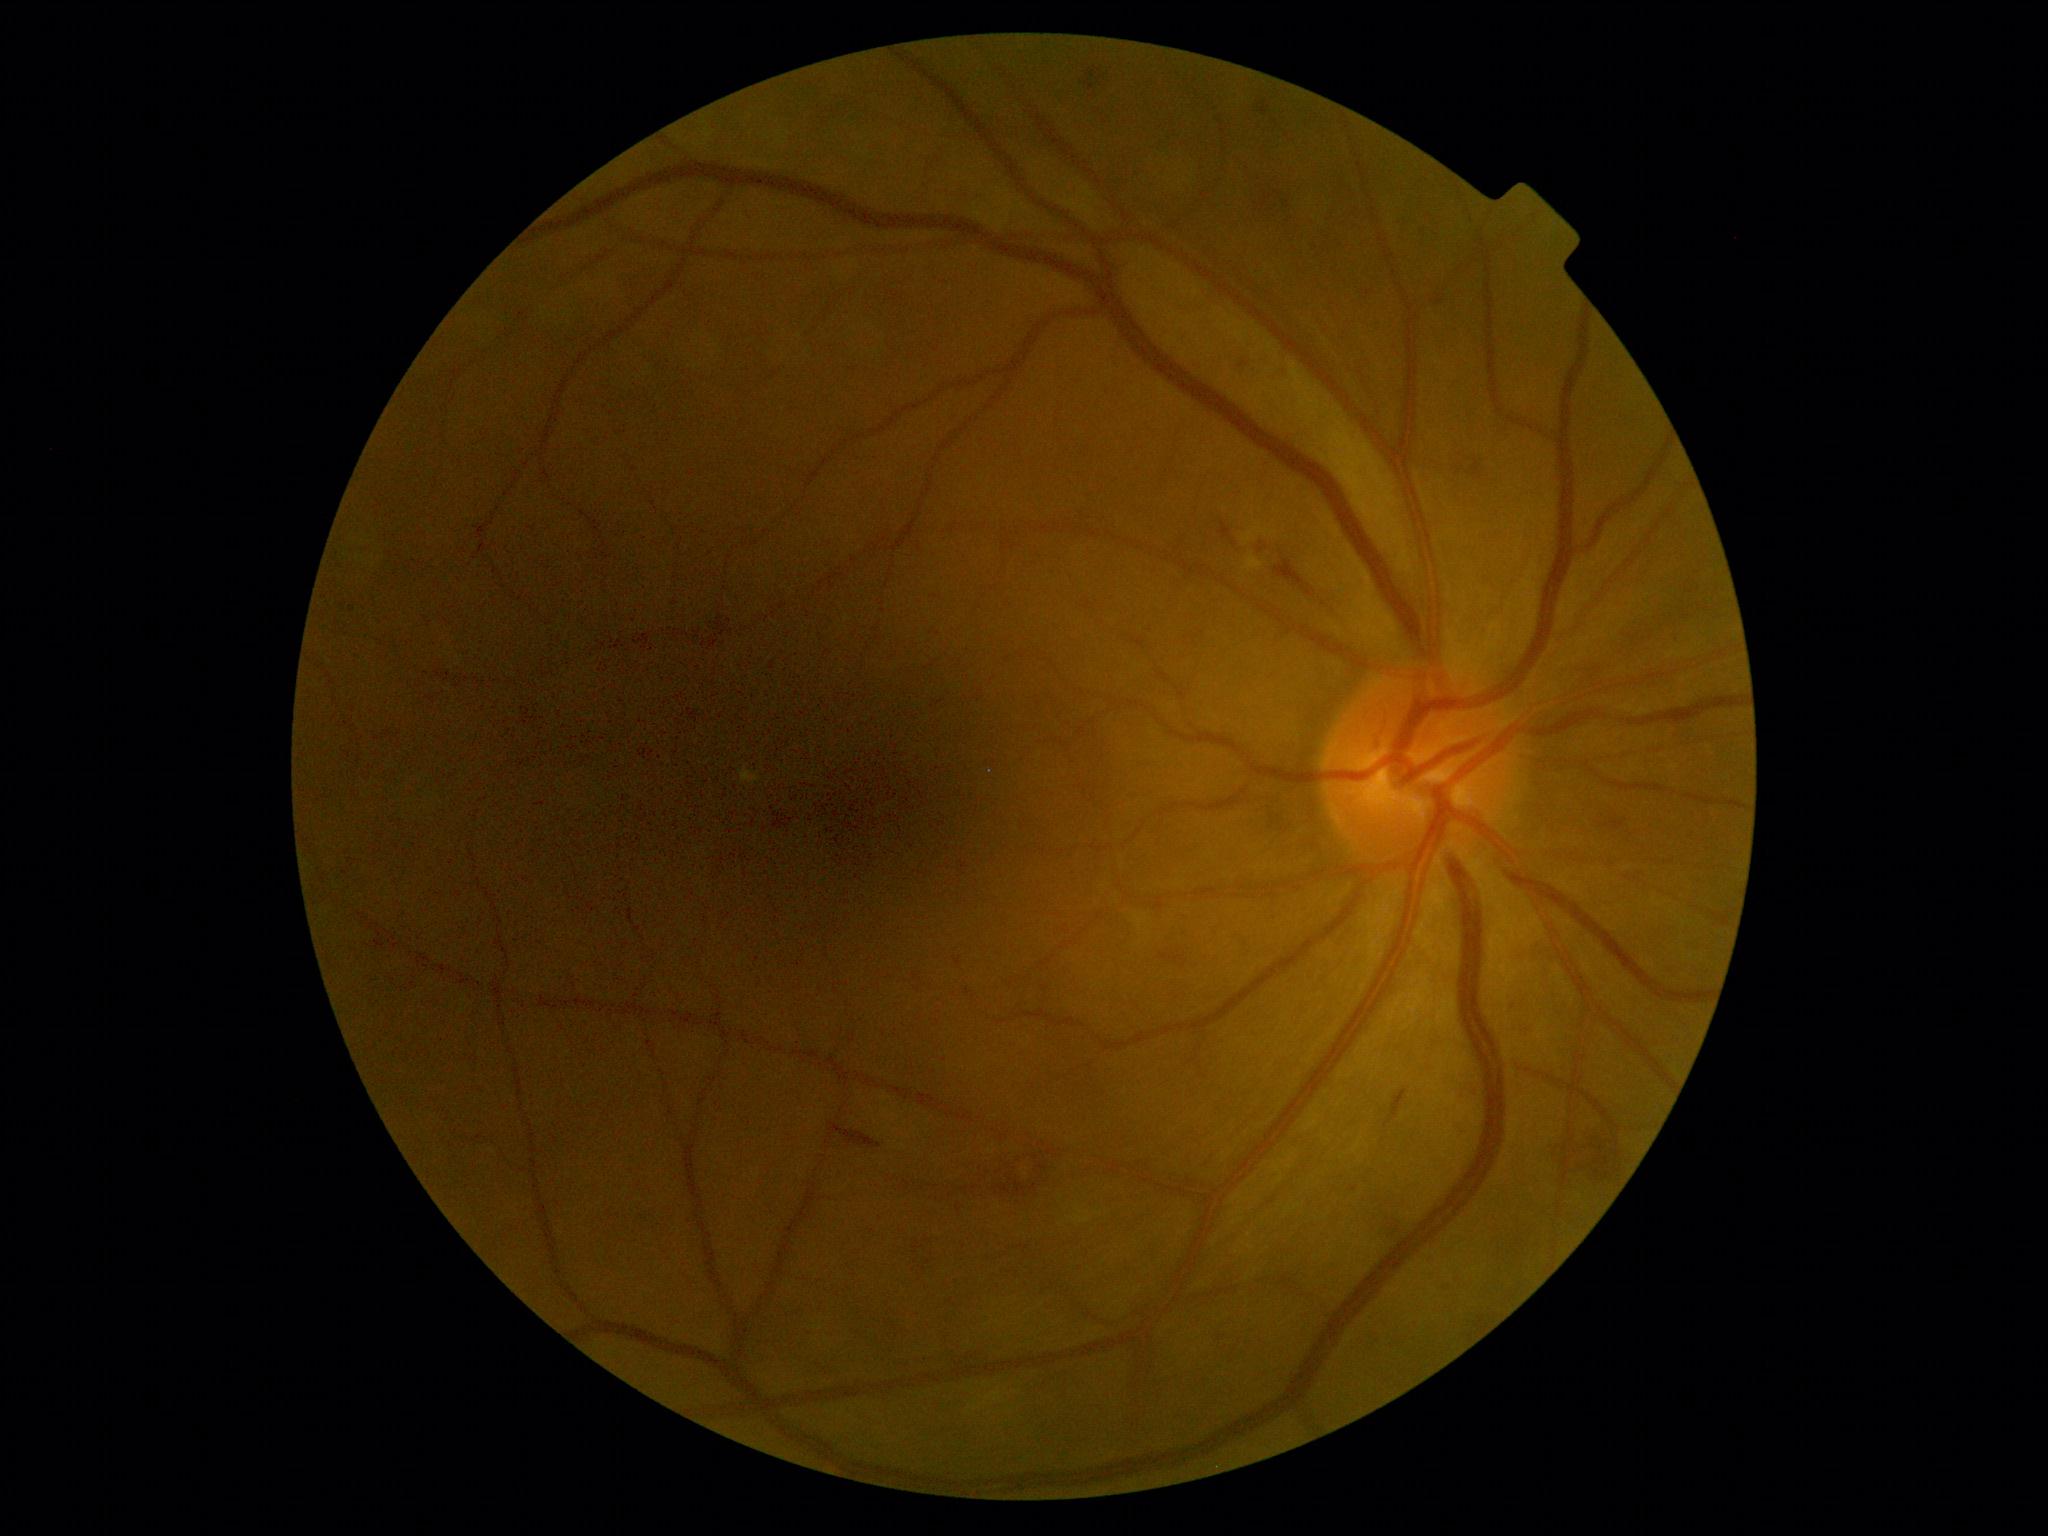

dr_grade: moderate NPDR (grade 2)